Topcon TRC-50DX. 50° field of view
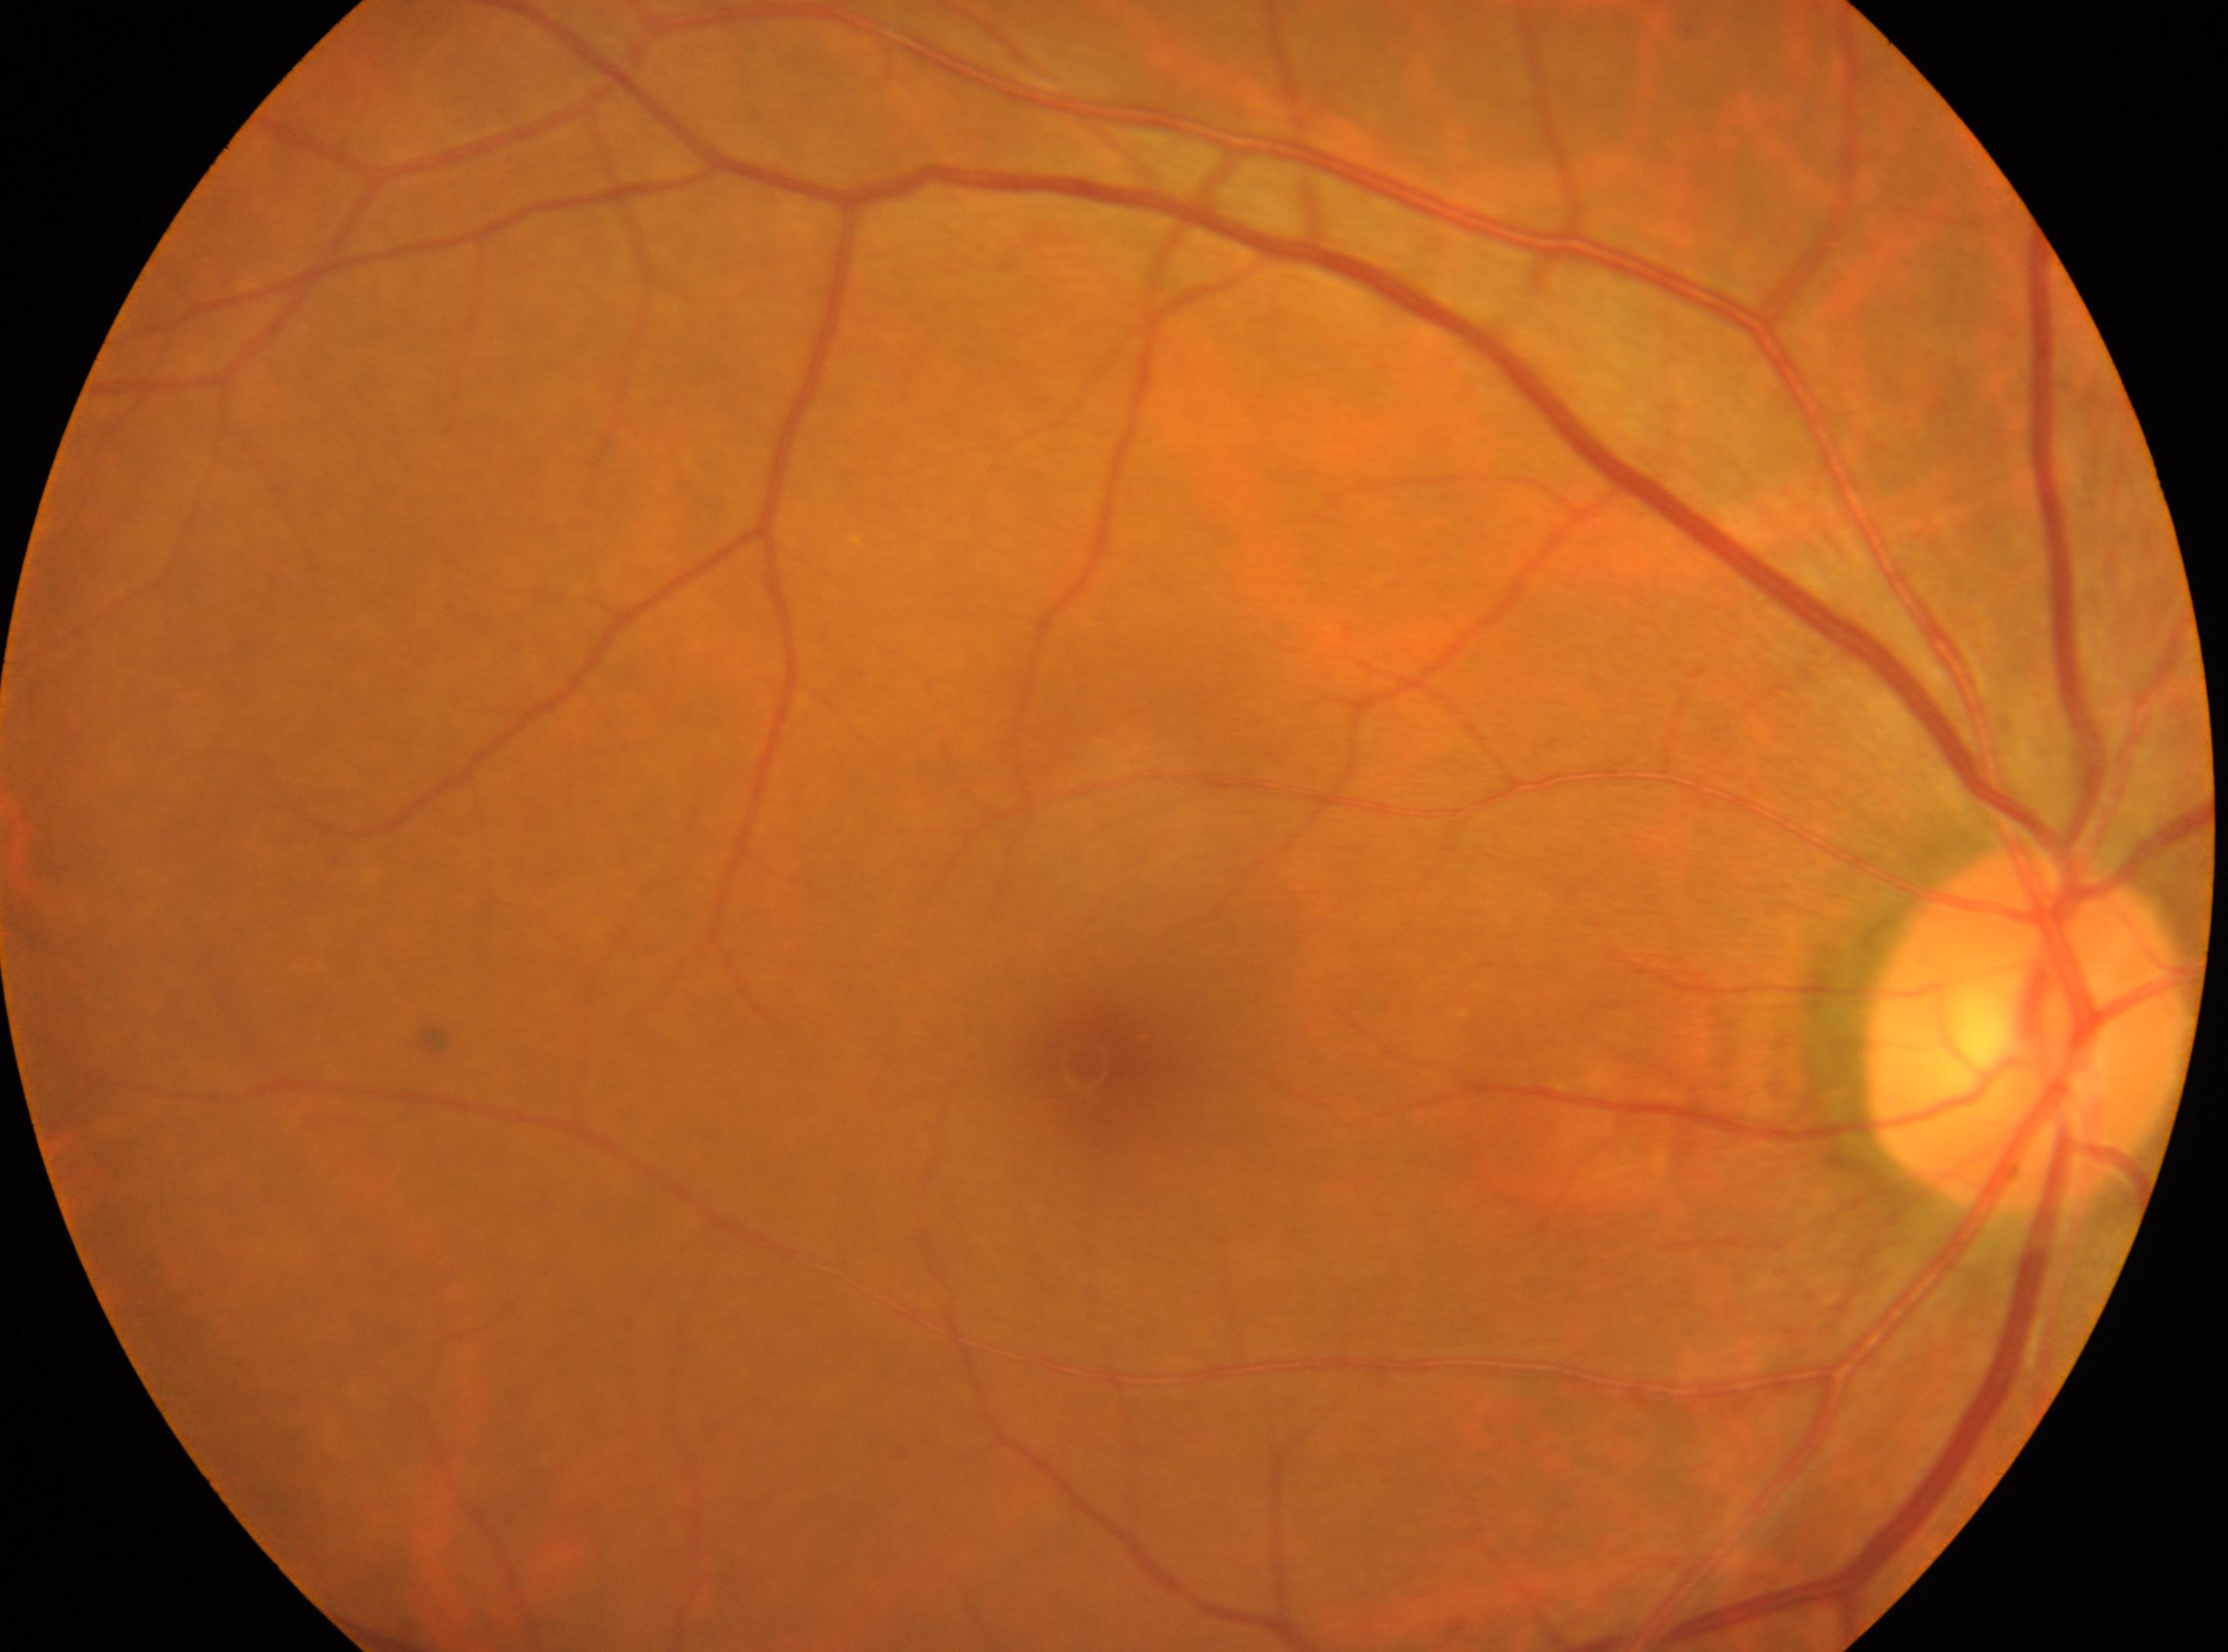 Eye: OD.
Optic disc: [2025, 1026].
Fovea centralis located at [1086, 1064].
Diabetic retinopathy (DR): no apparent diabetic retinopathy (grade 0).